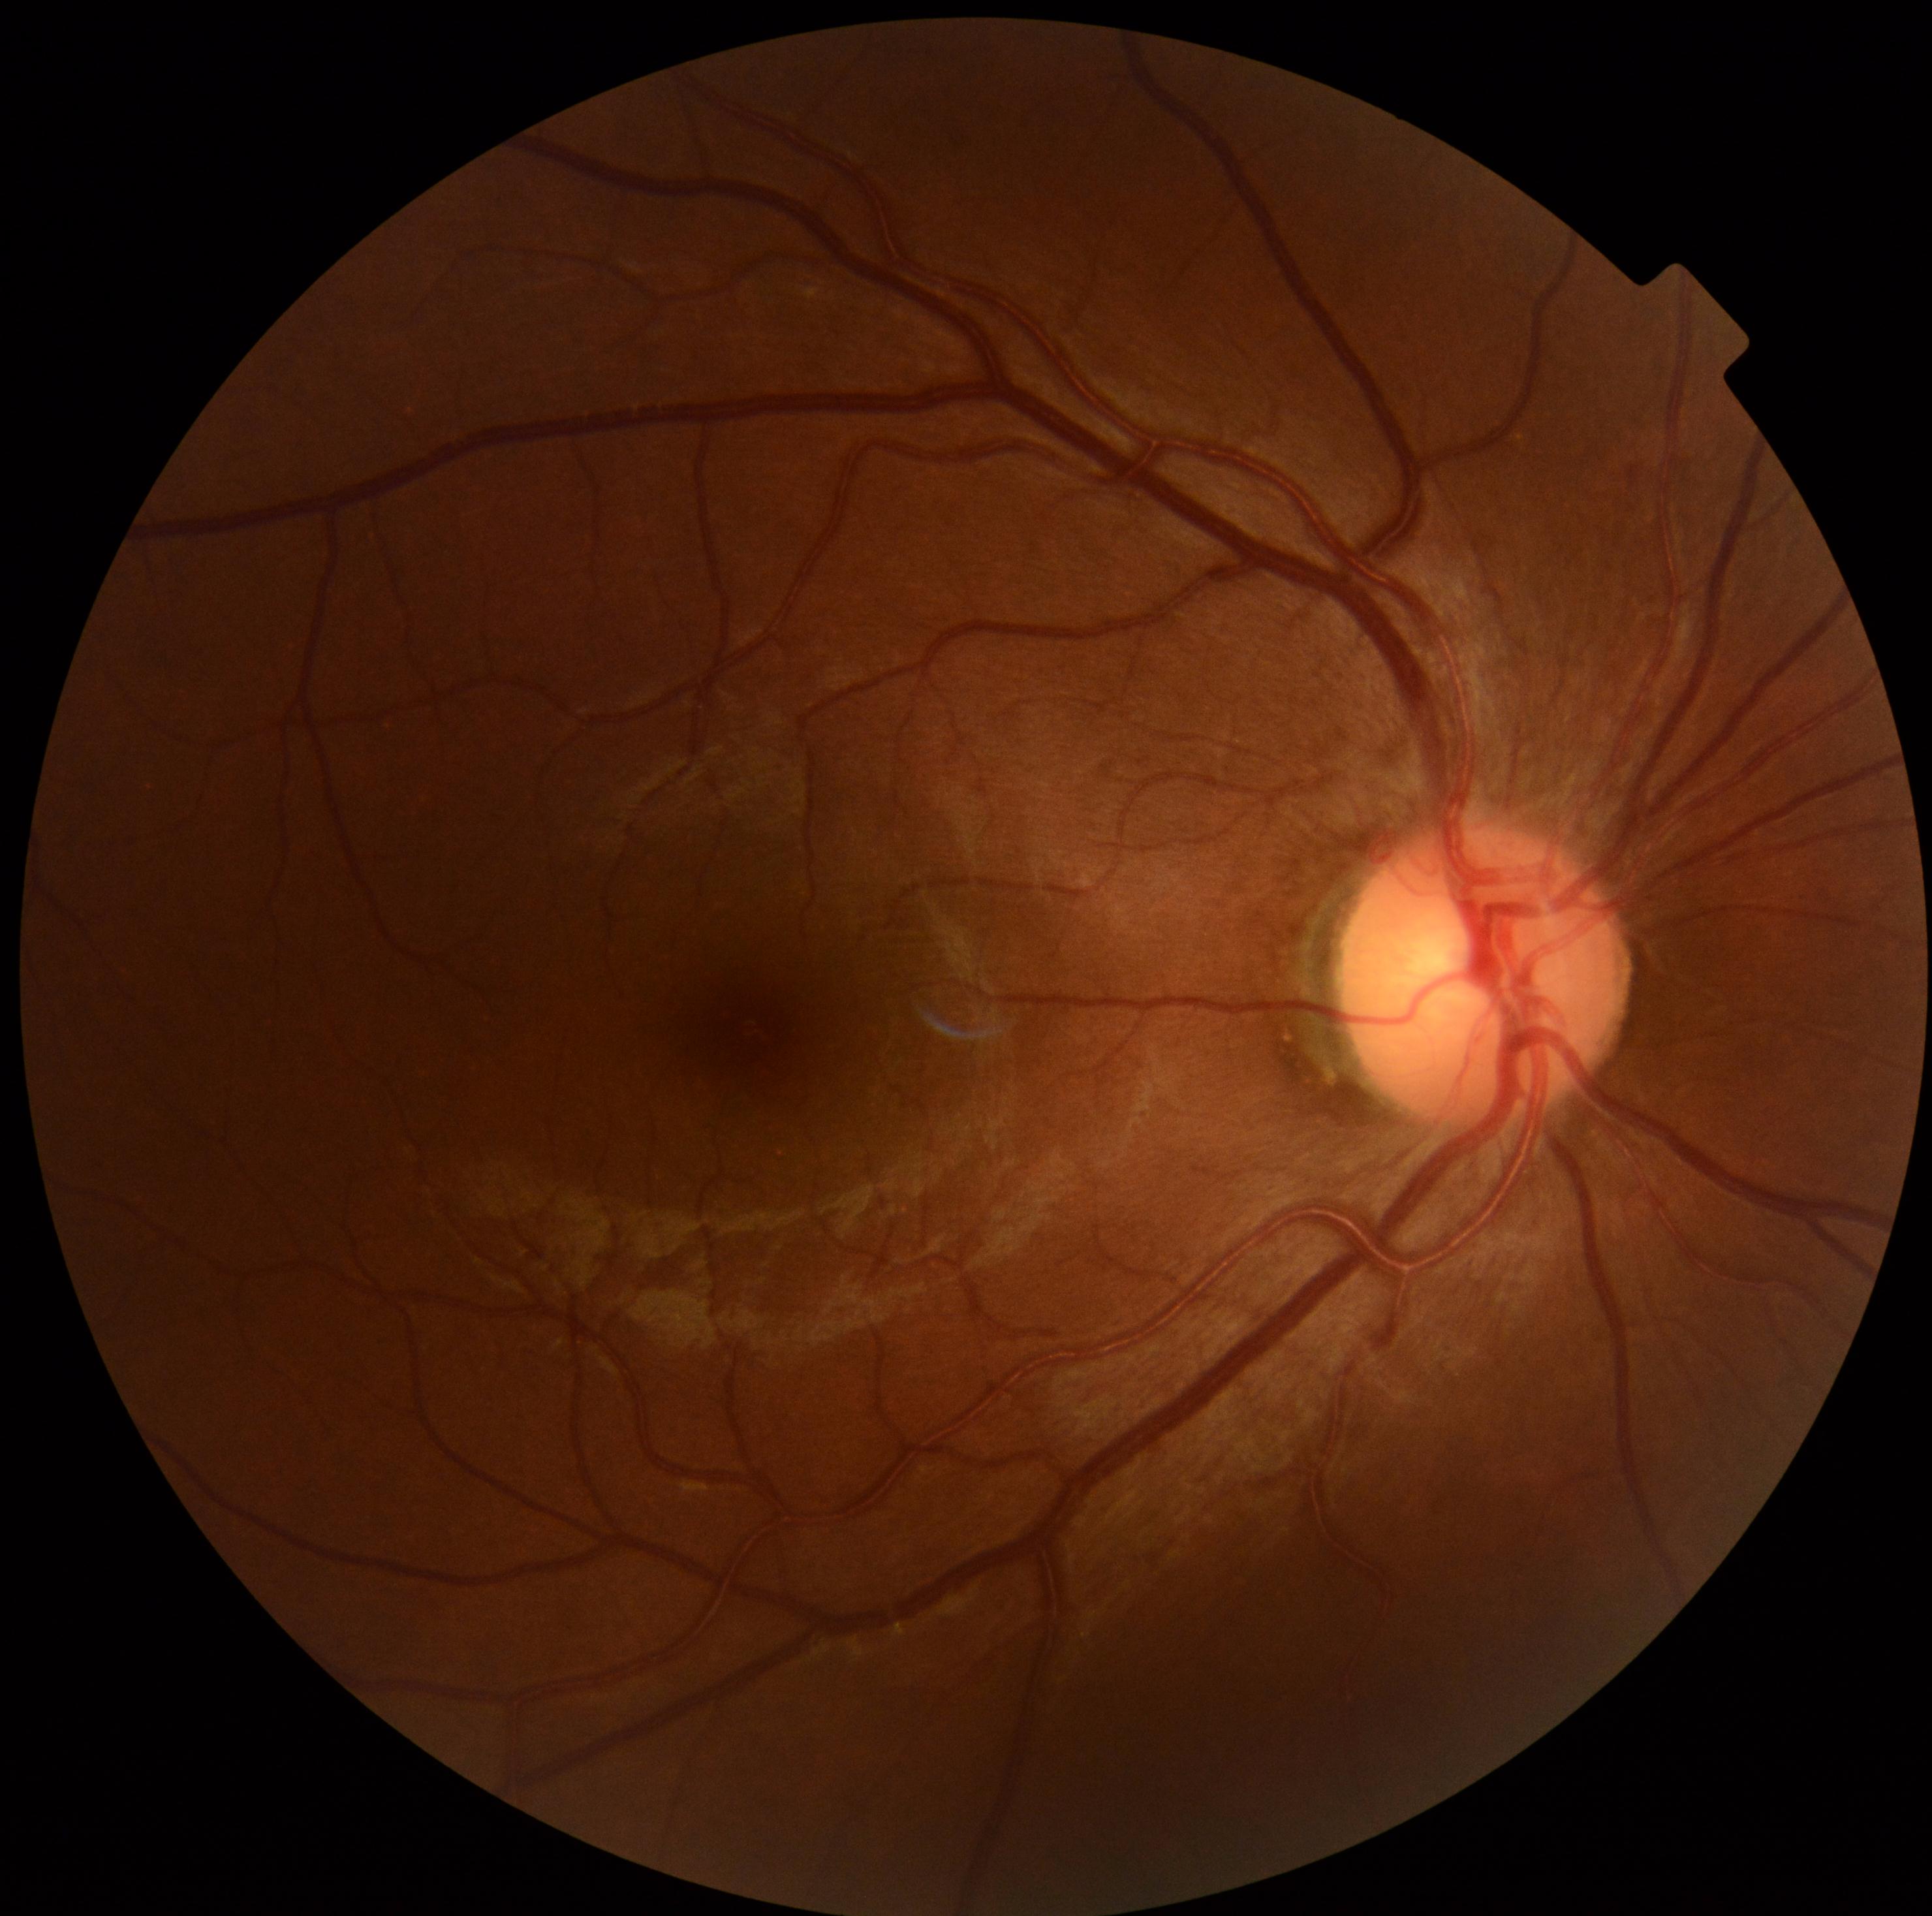

Findings:
- DR severity — grade 0 (no apparent retinopathy)